Acquired with a Remidio FOP fundus camera; 1659x2212 — 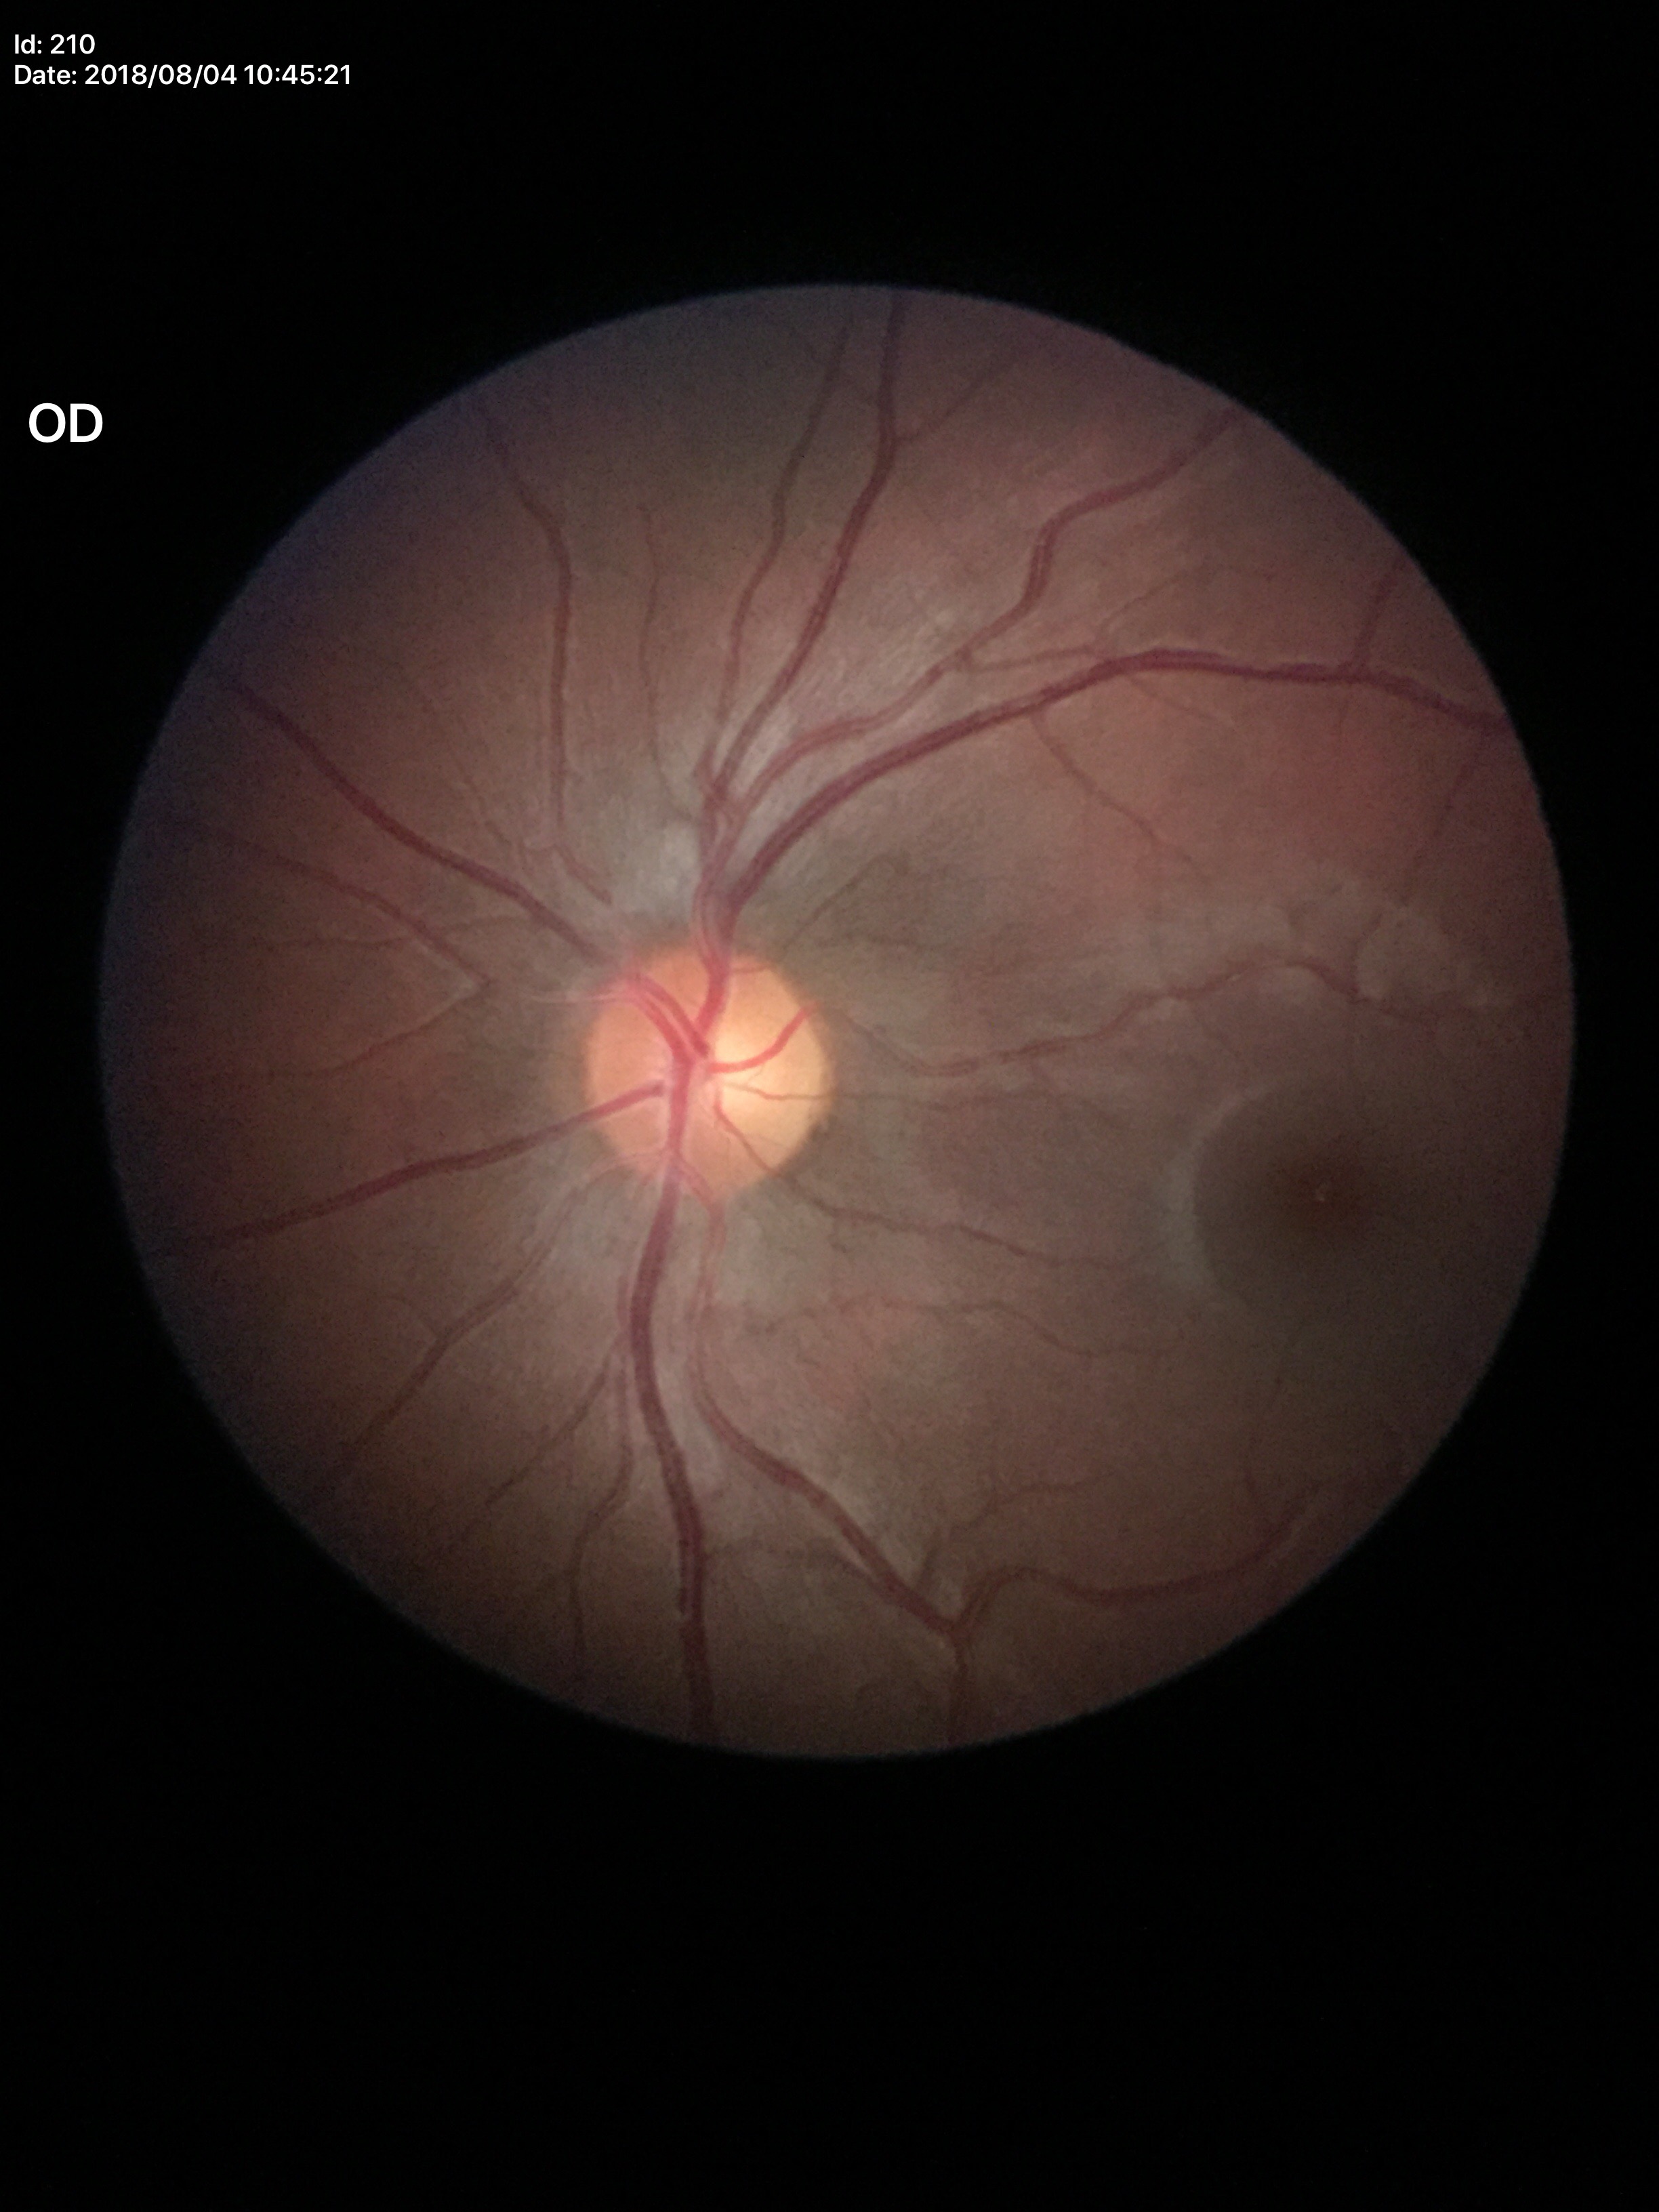 VCDR: 0.44.
Not suspicious for glaucoma (5/5 ophthalmologists in agreement).